Infant wide-field fundus photograph: 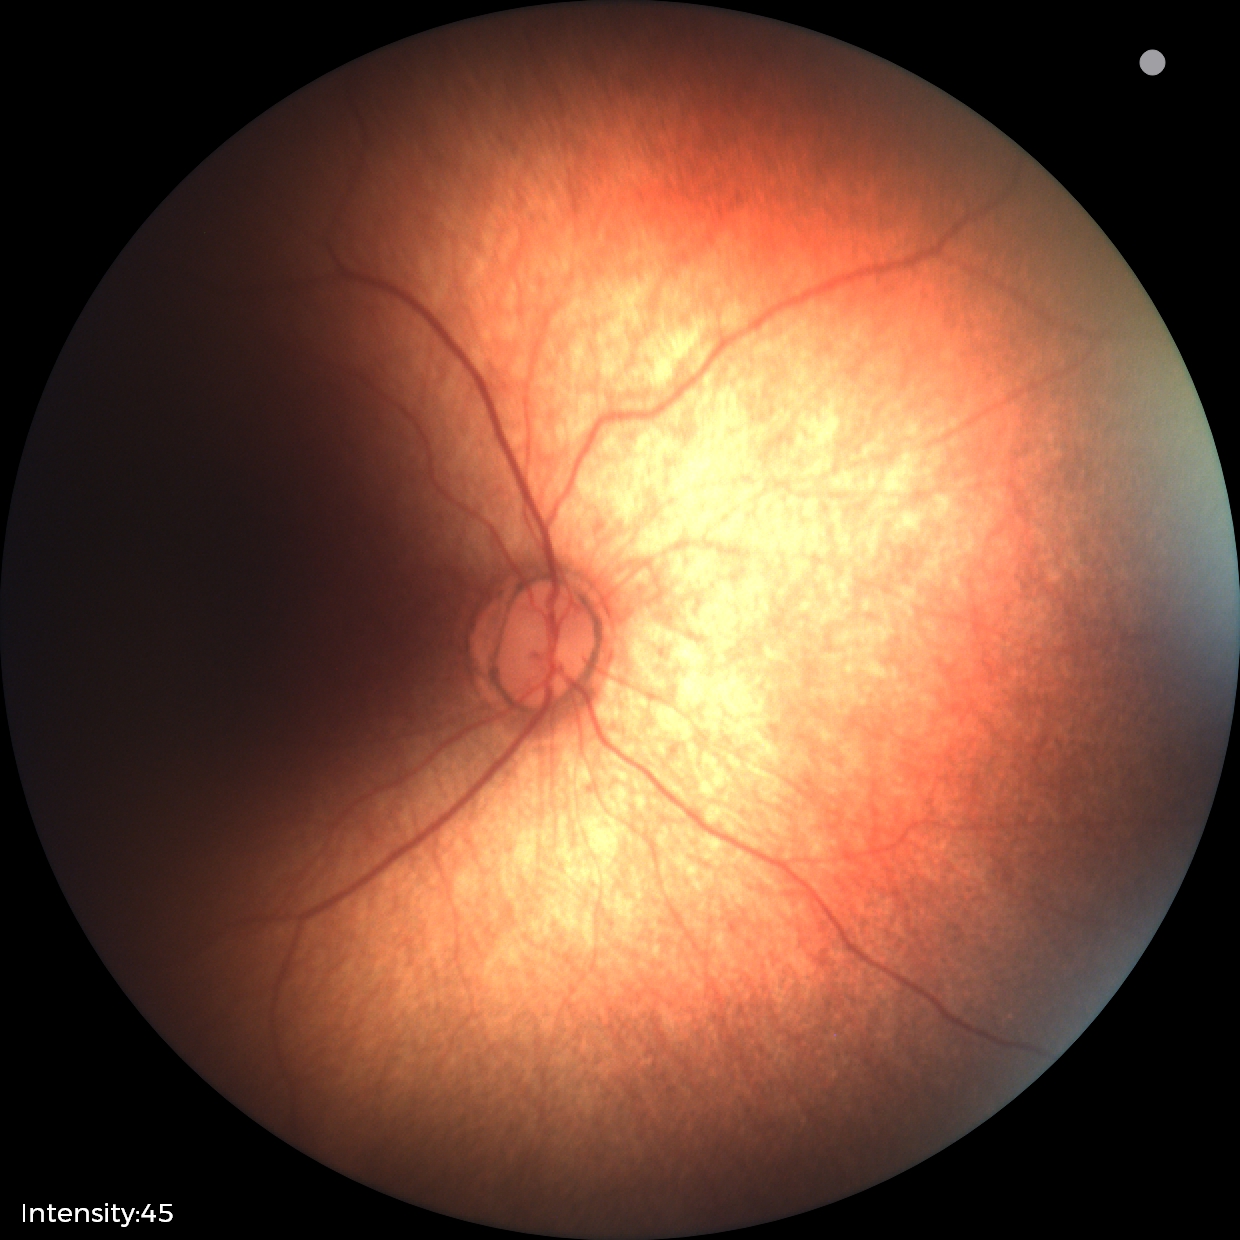 Normal screening examination.